Image size 640x480; captured with the Clarity RetCam 3 (130° field of view); wide-field fundus image from infant ROP screening.
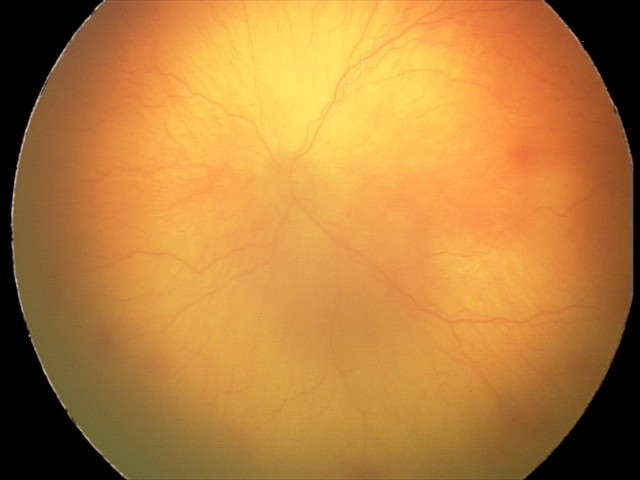
Examination diagnosed as aggressive retinopathy of prematurity.
Plus disease present.